Fundus photo:
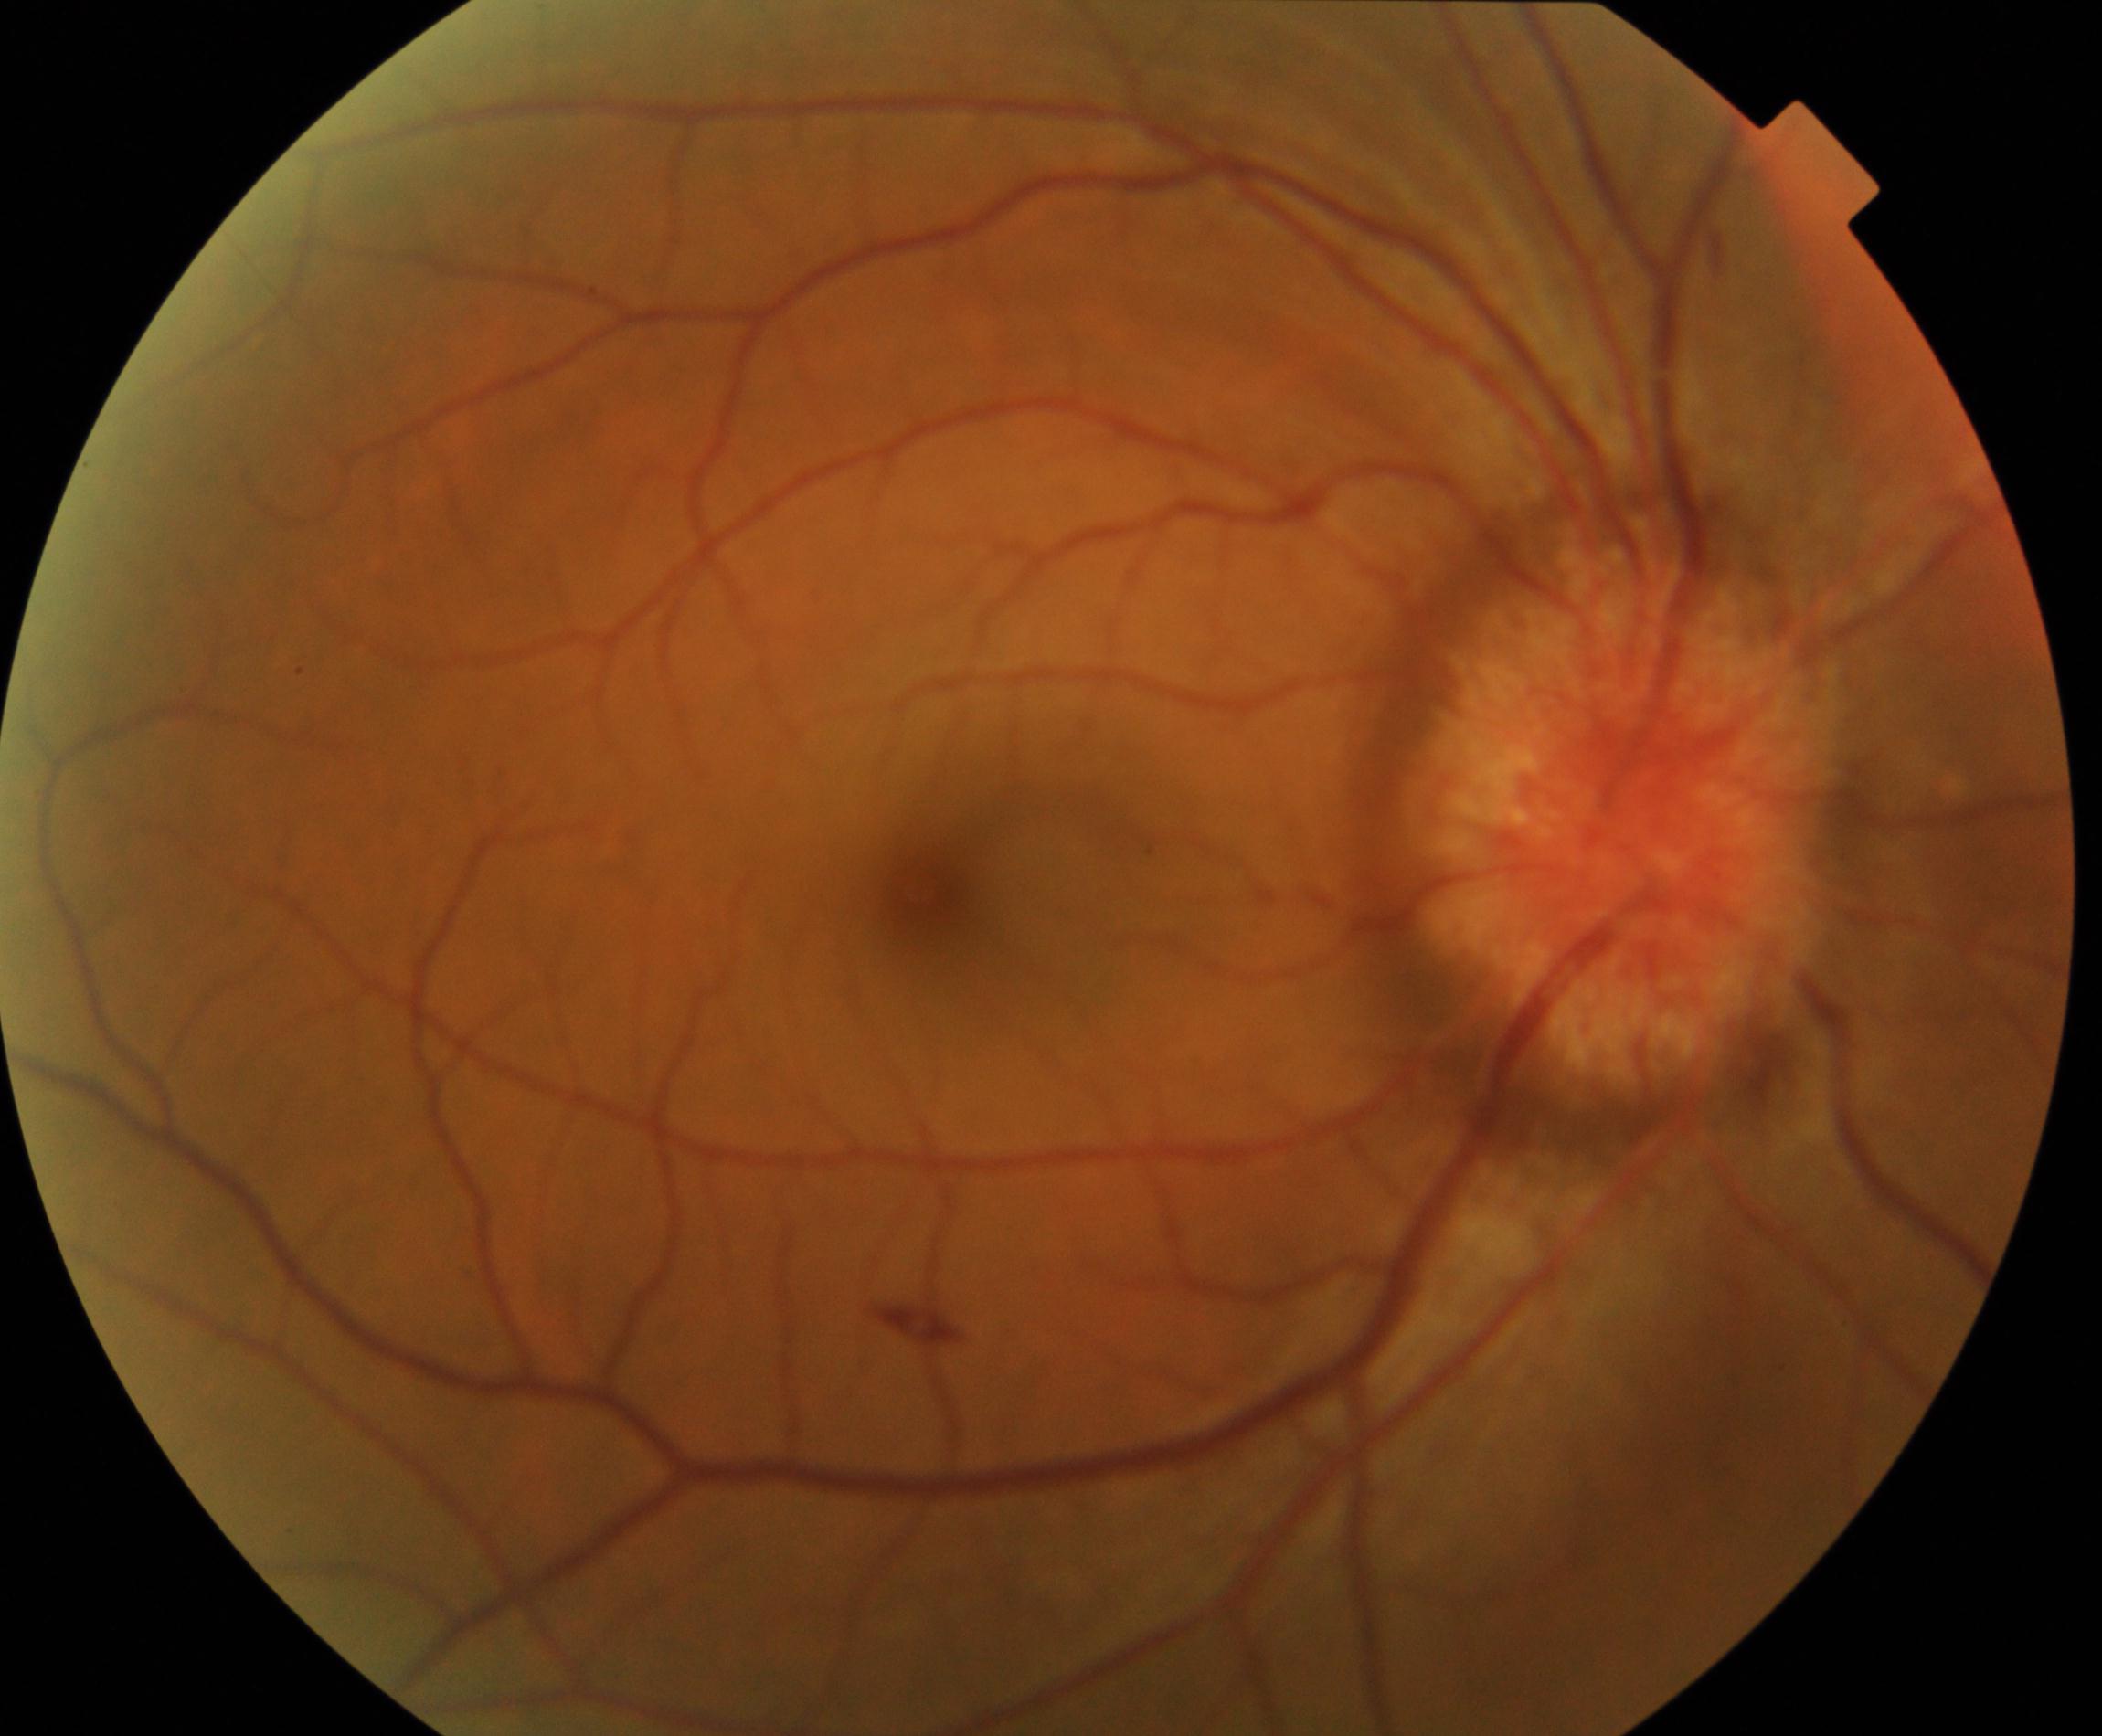

Primary finding: disc swelling and elevation.